Retinal fundus photograph:
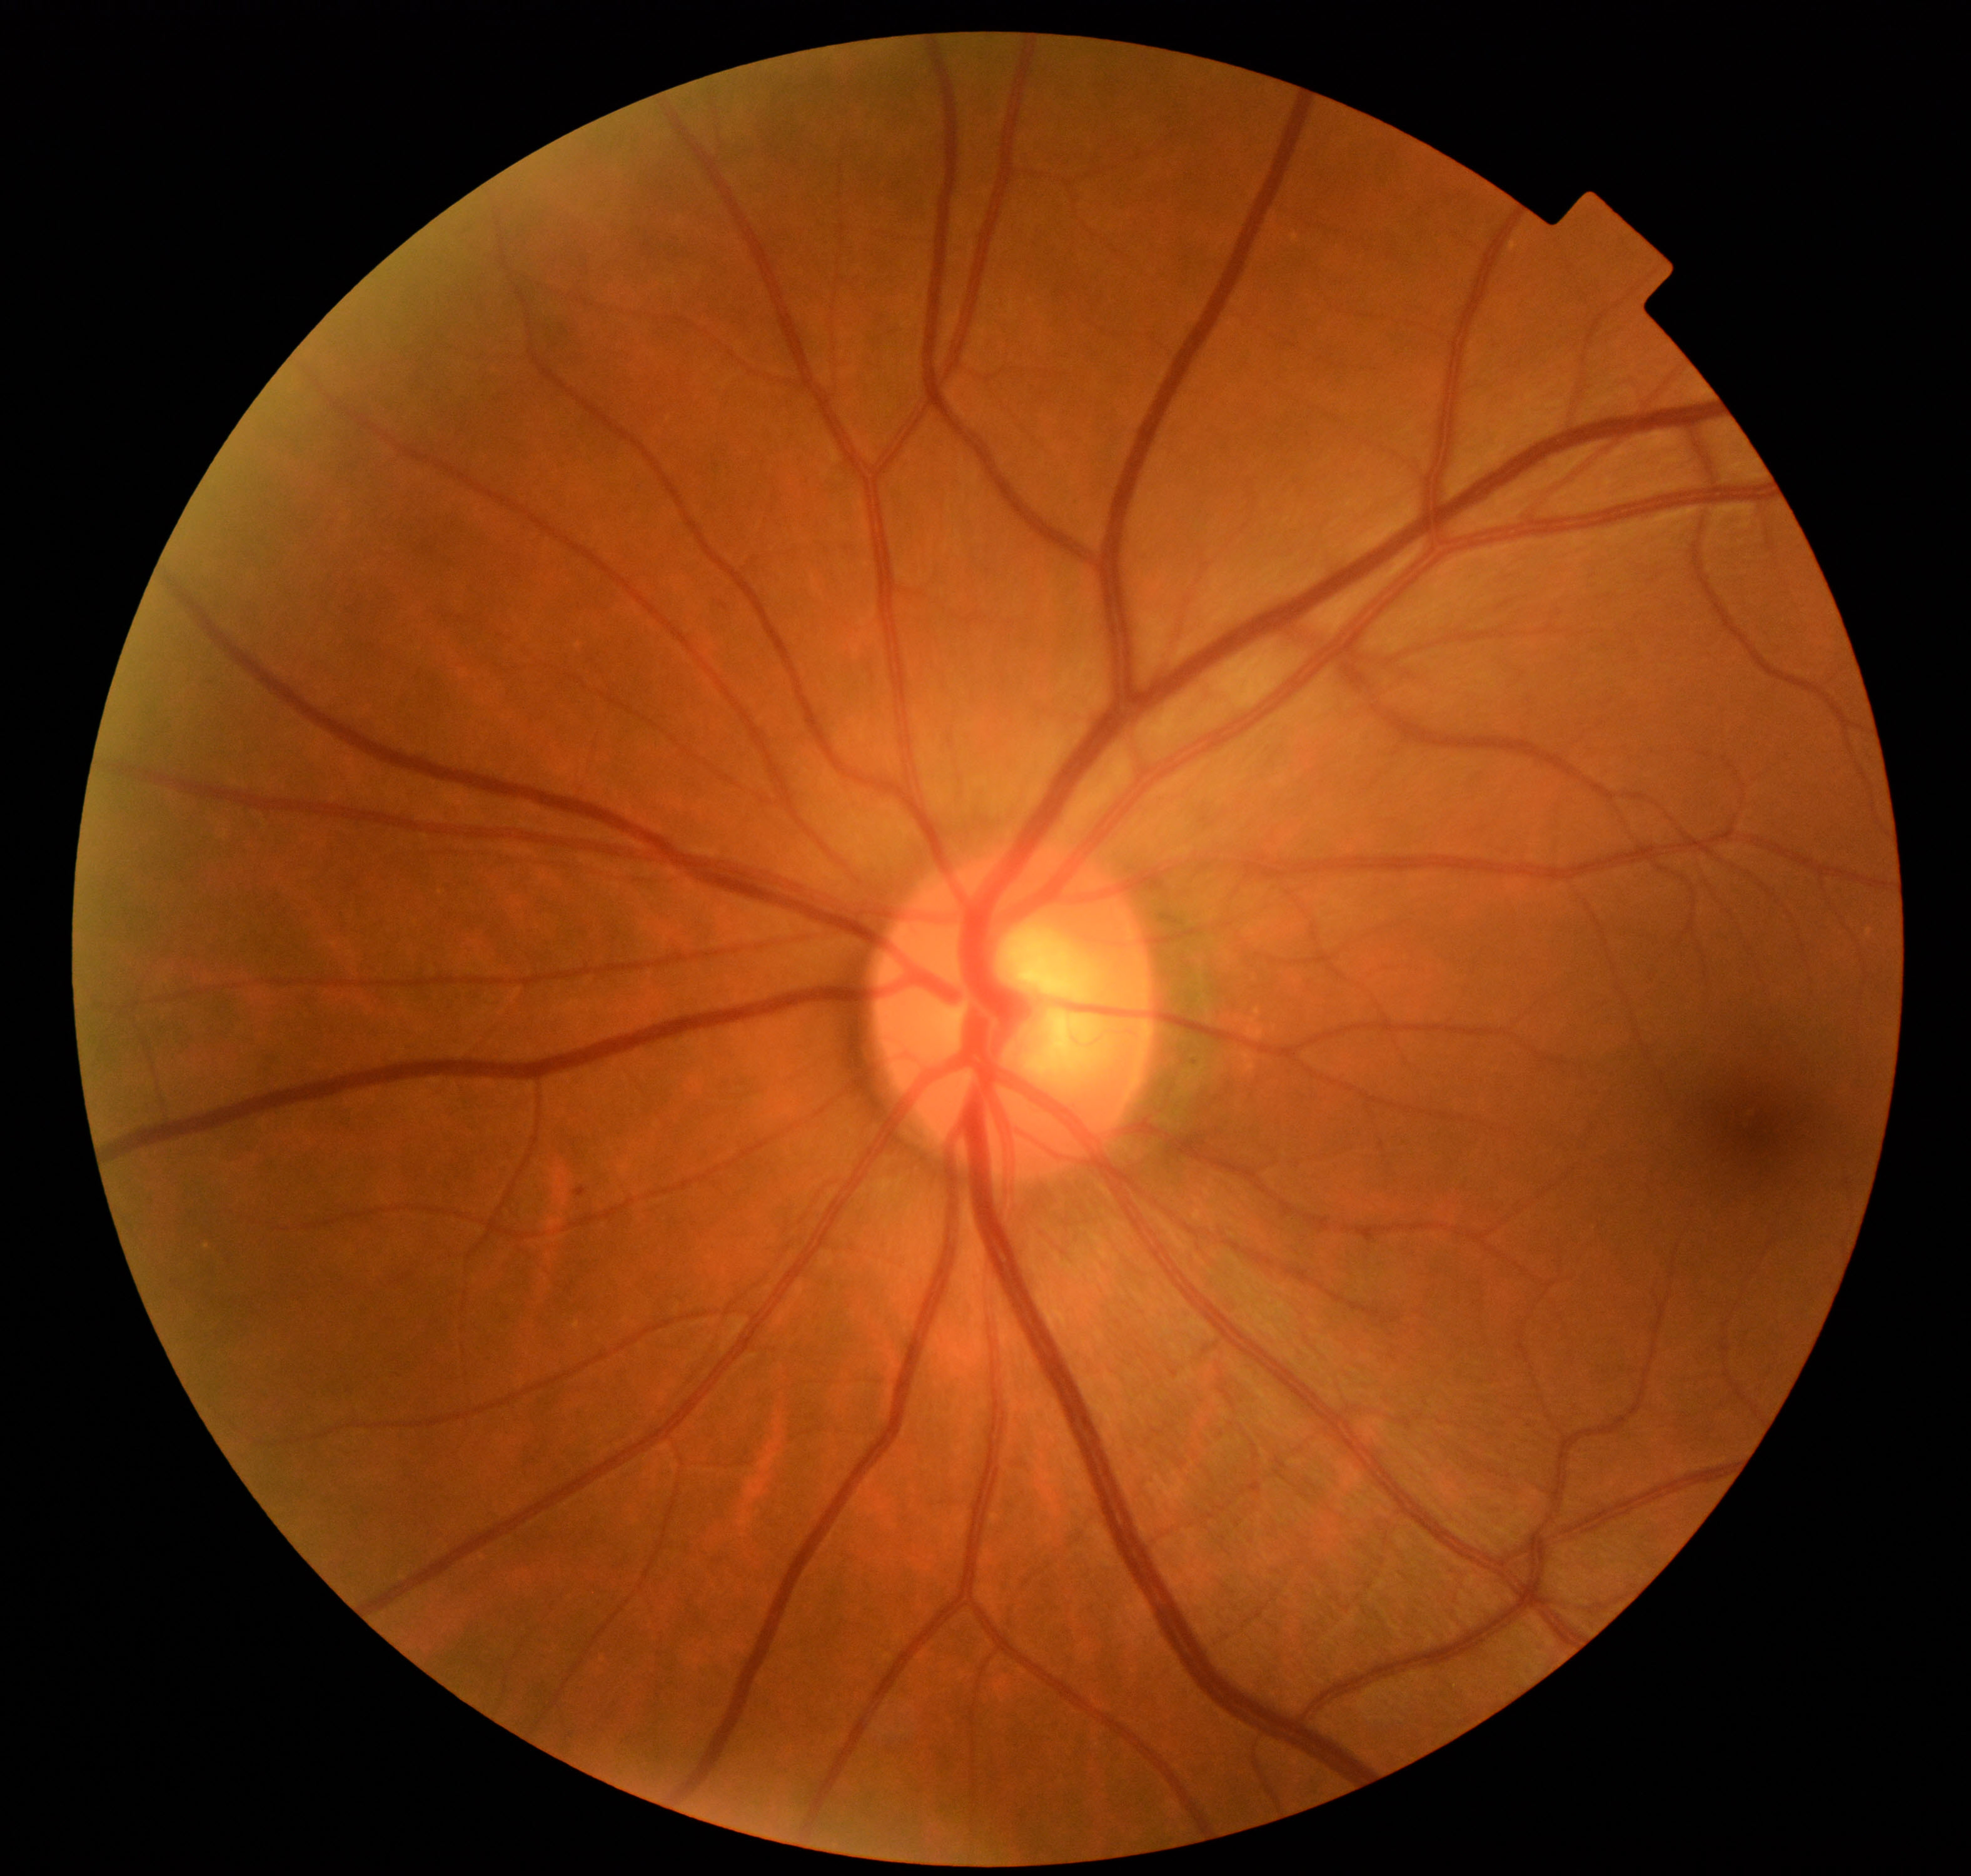

Impression: mild non-proliferative diabetic retinopathy. Defined by microaneurysms only (International Classification of Diabetic Retinopathy, 2017).